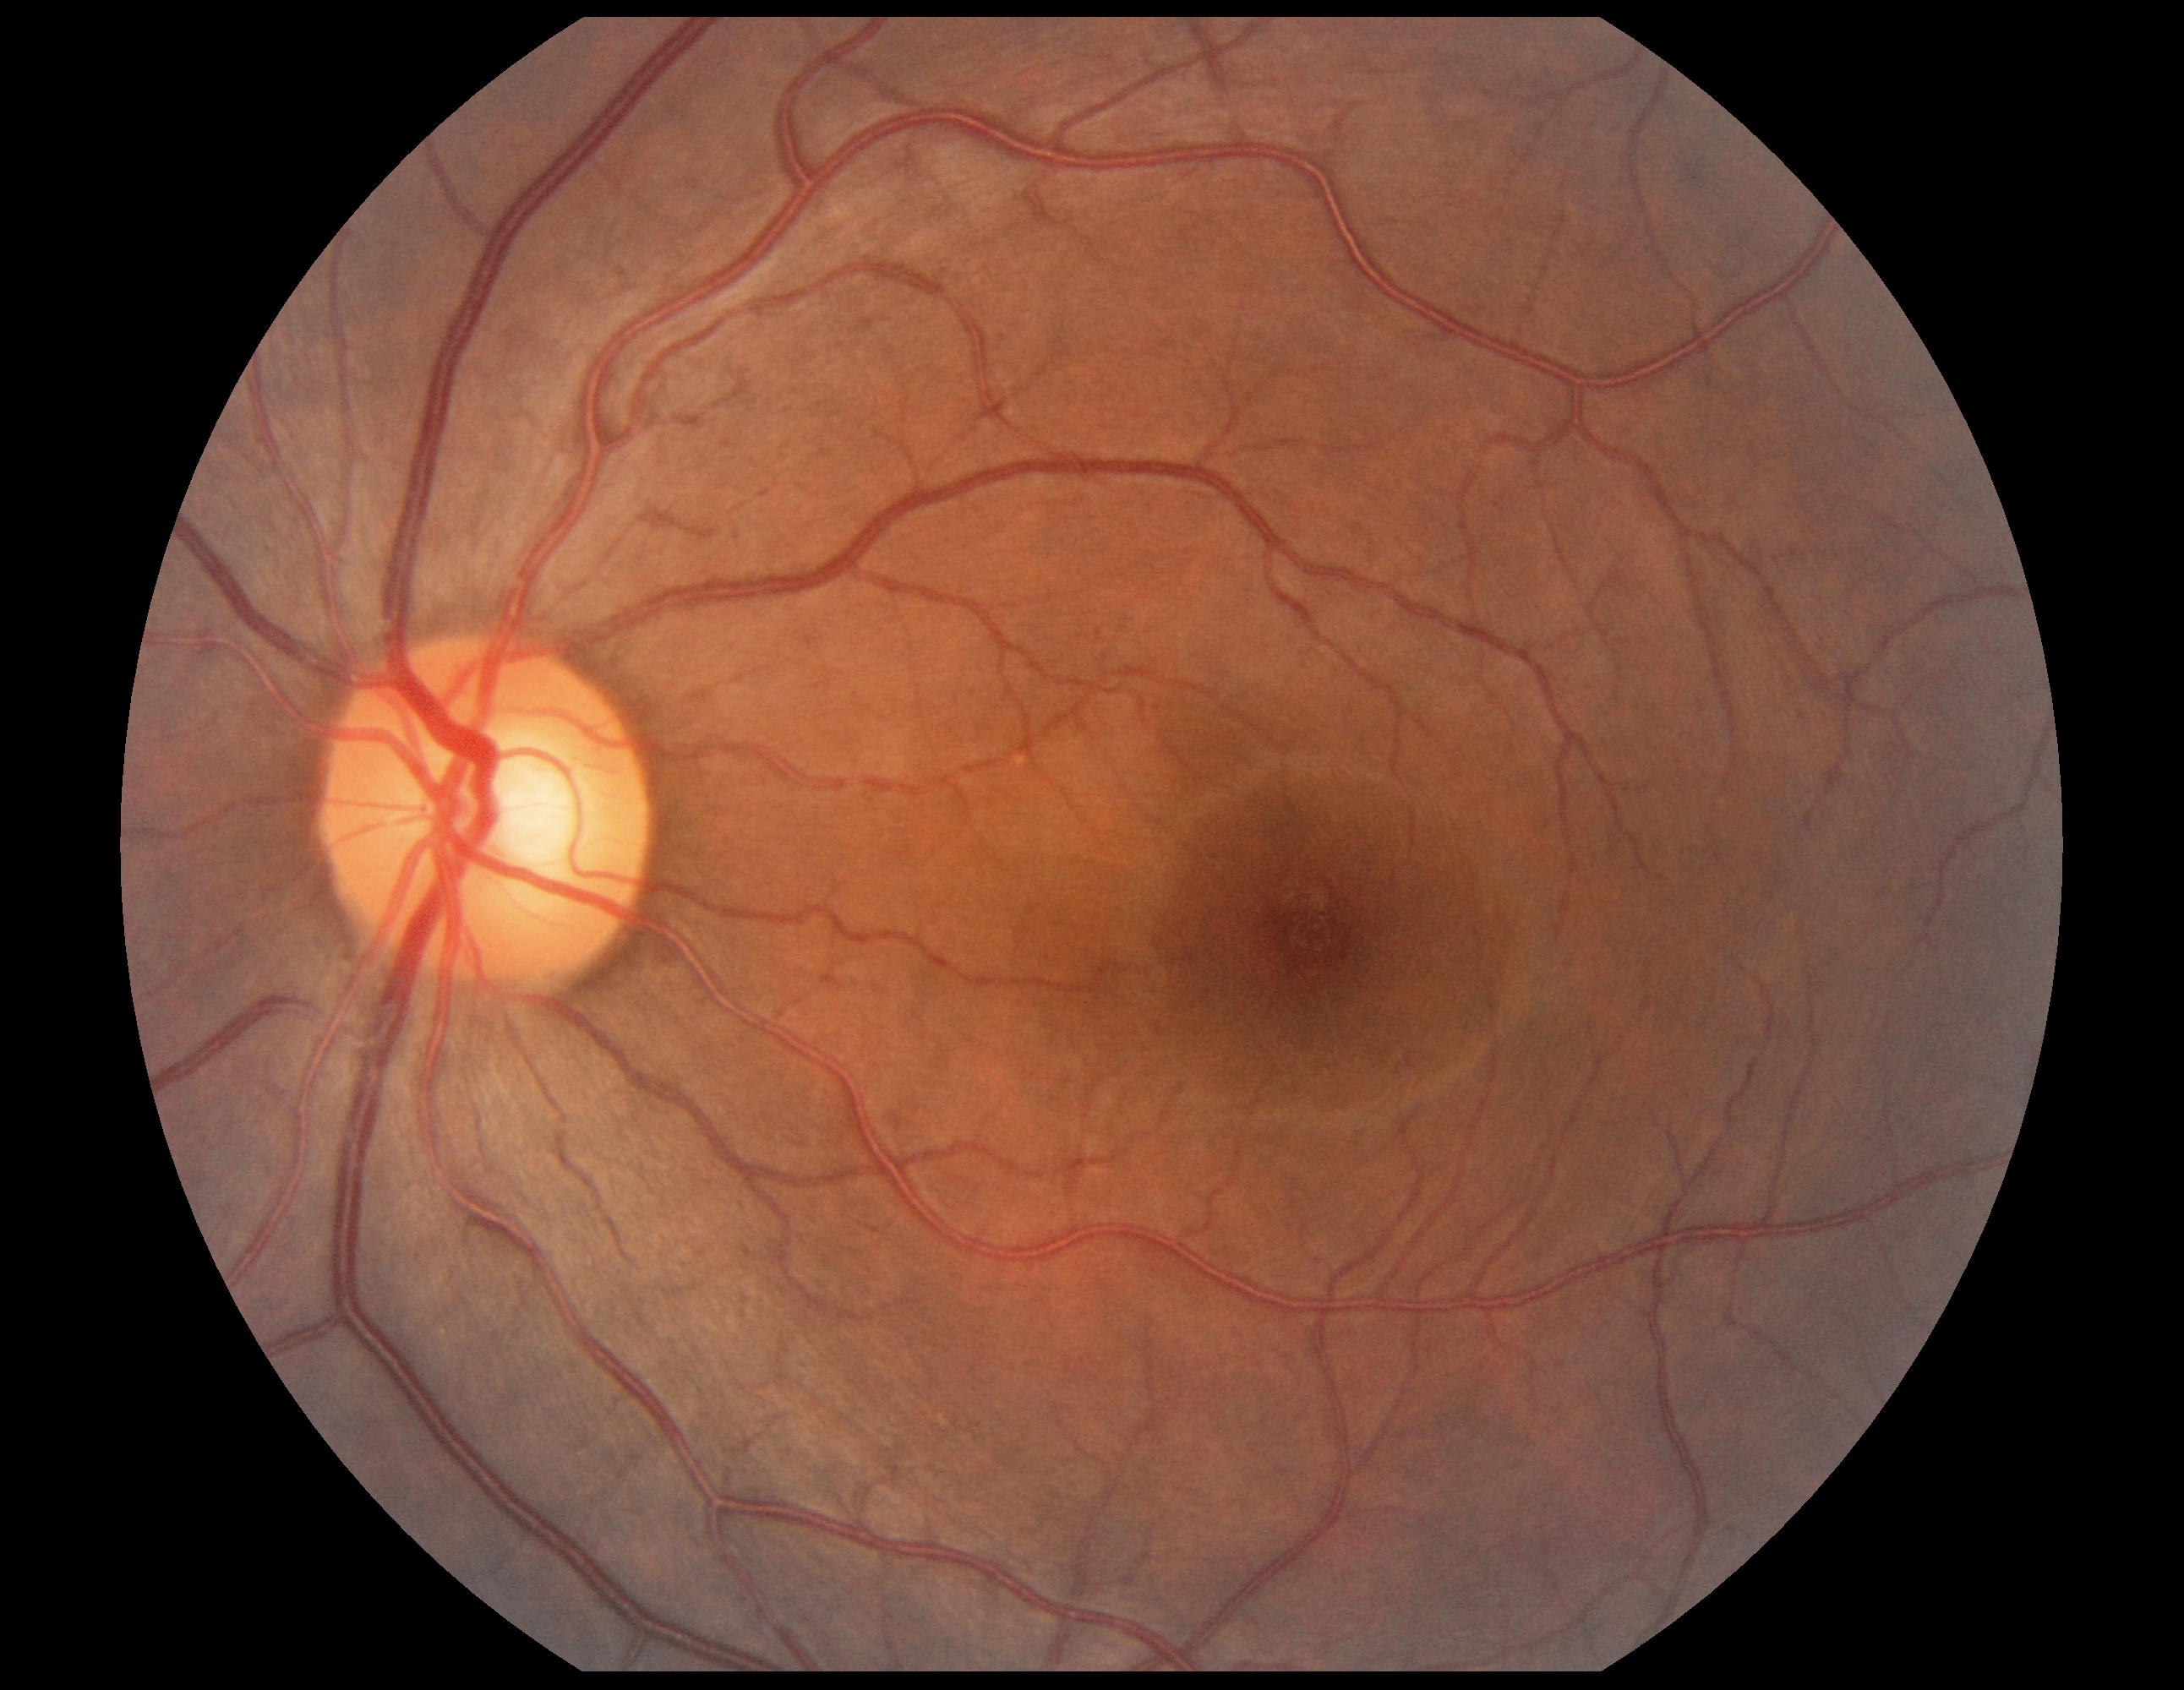
{
  "dr_impression": "no signs of DR",
  "dr_grade": "0/4"
}